Retinal fundus photograph: 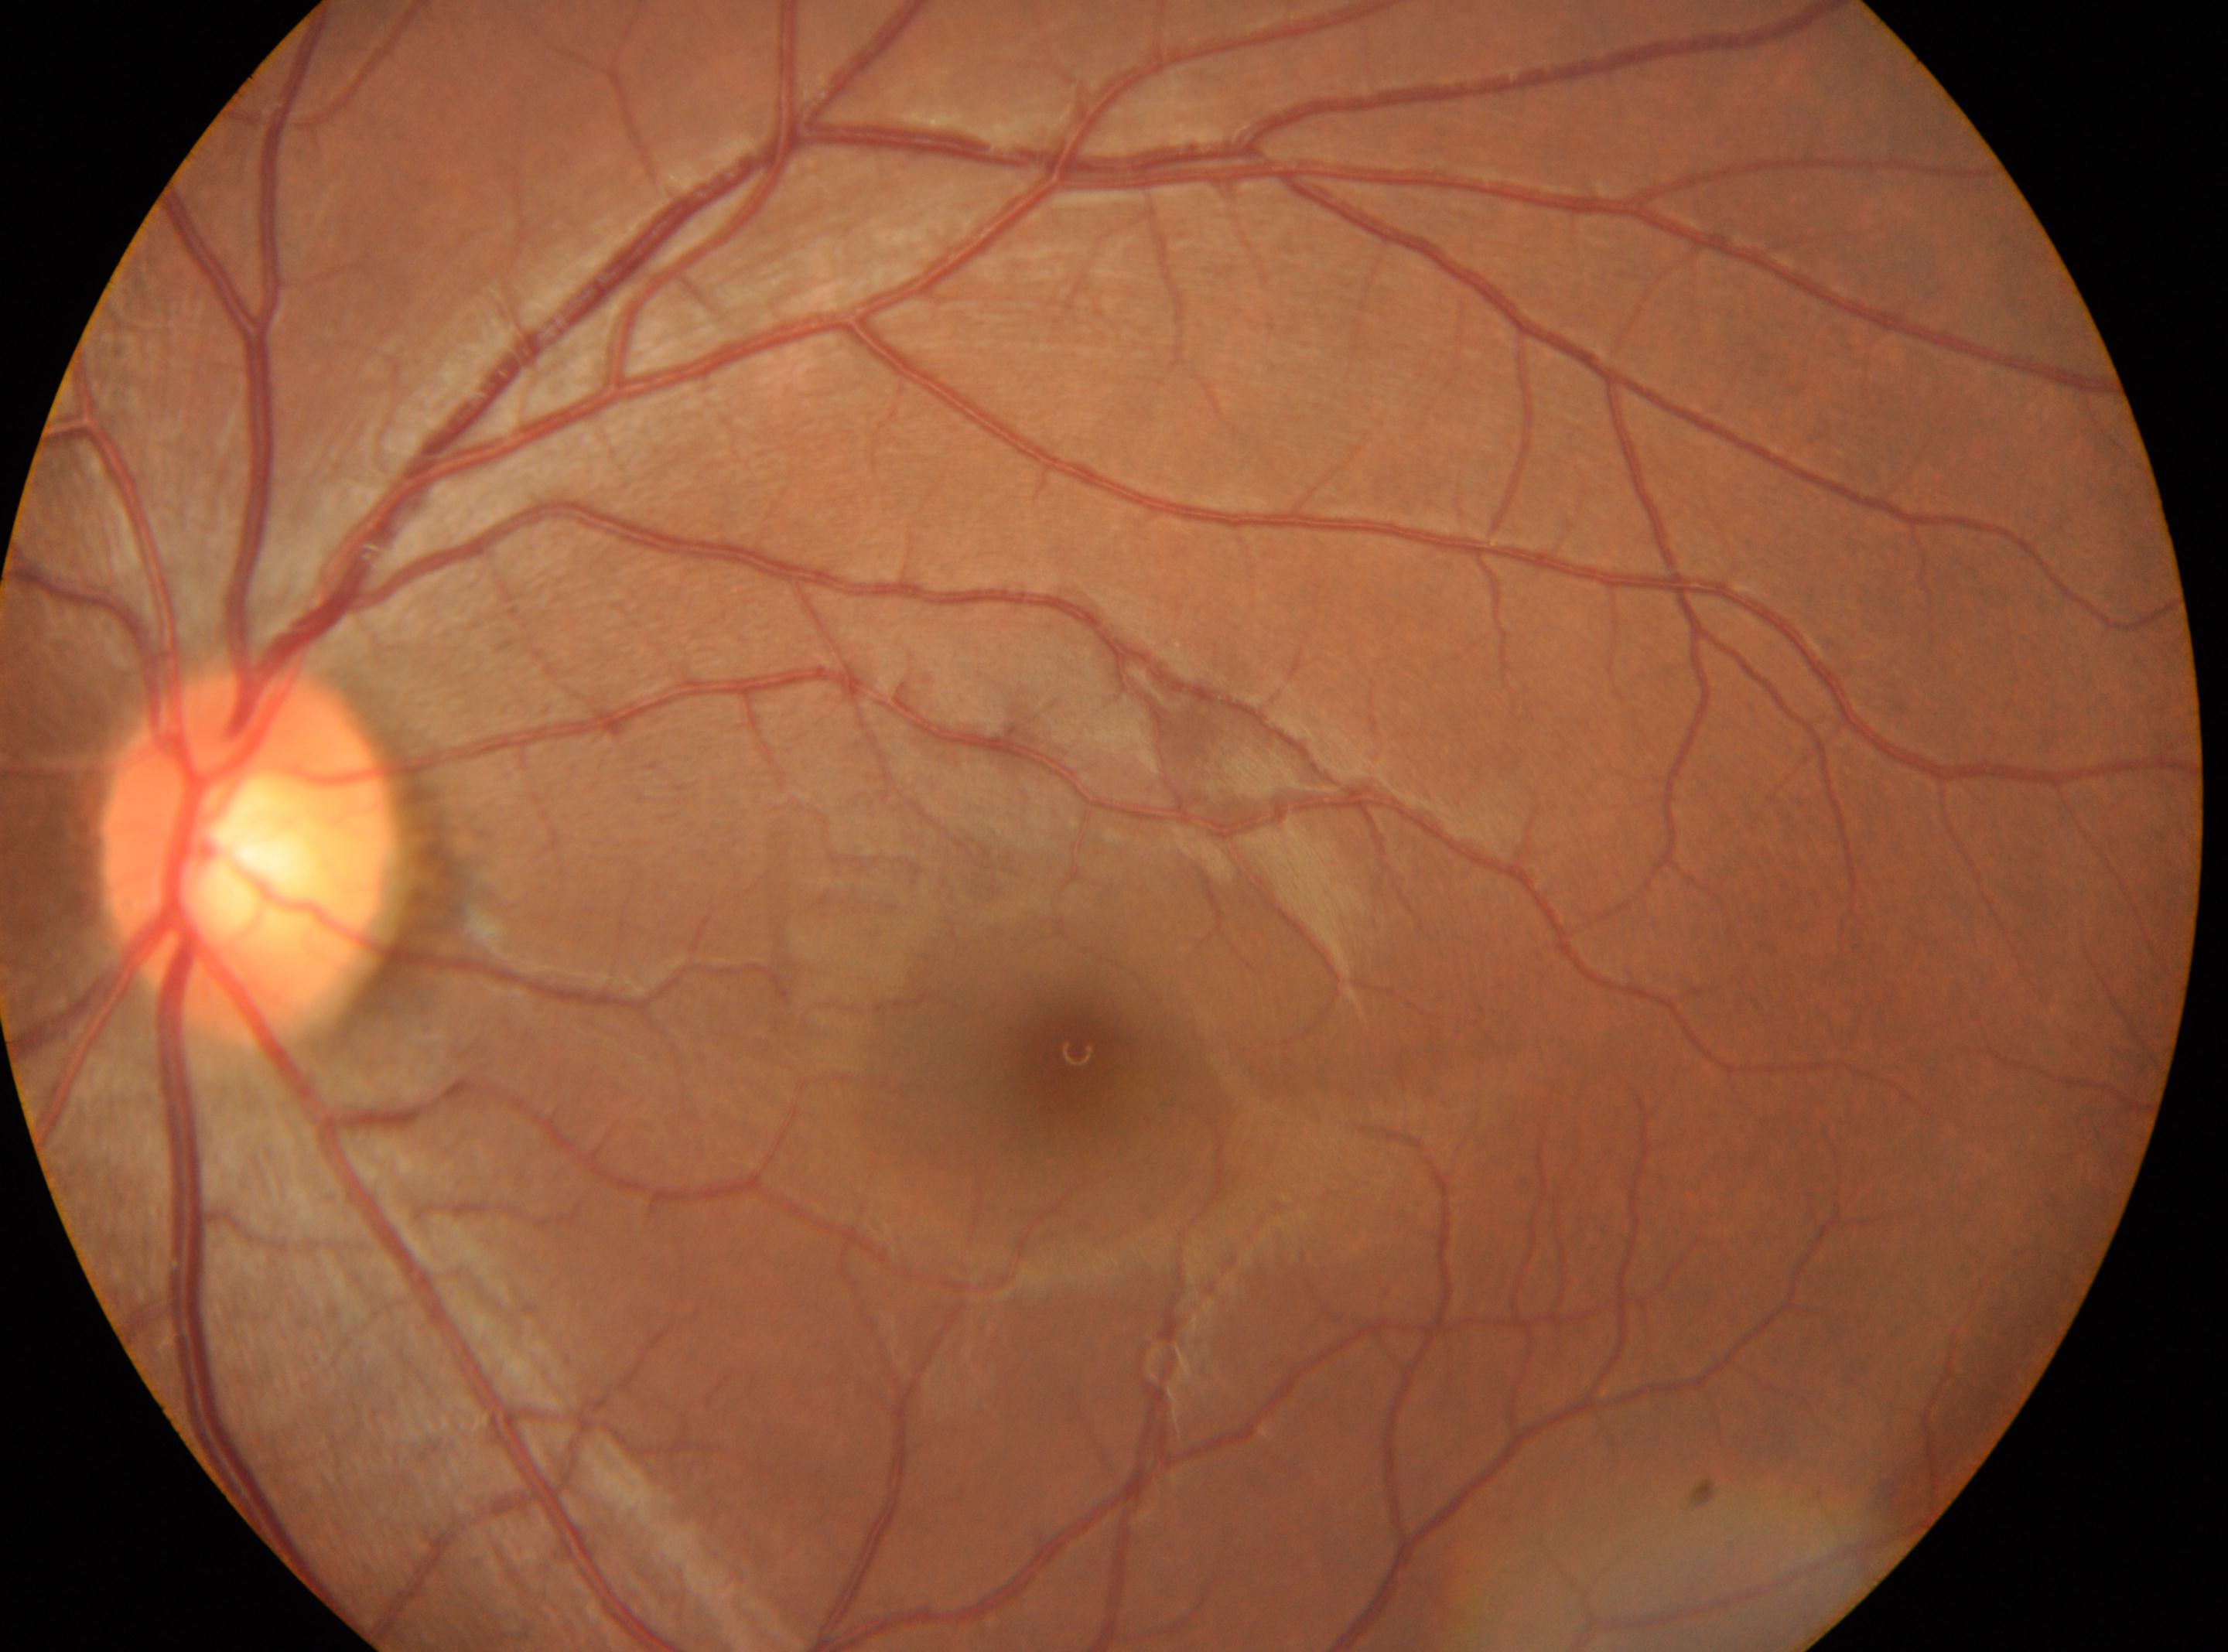

Findings:
• the optic disc: (247, 854)
• fovea: (1077, 1052)
• laterality: the left eye
• DR grade: 0 (no apparent retinopathy)